Image size 1240x1240. 100° field of view (Phoenix ICON). Pediatric wide-field fundus photograph — 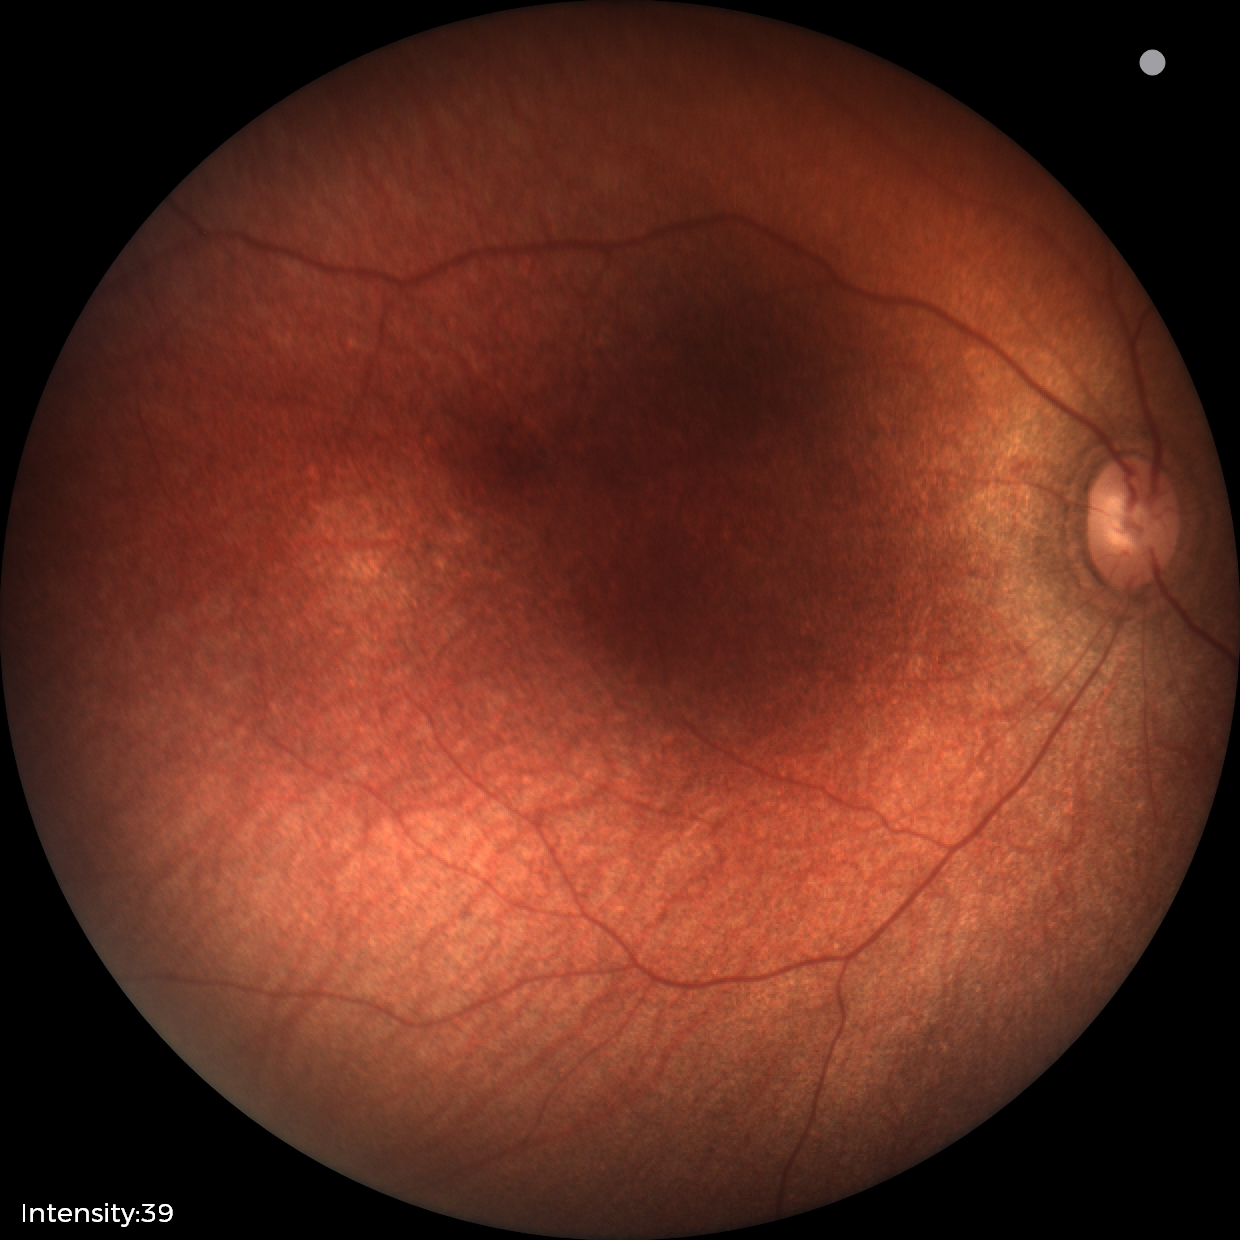 Physiological retinal appearance for postconceptual age.